Retinal fundus photograph; 1380x1382:
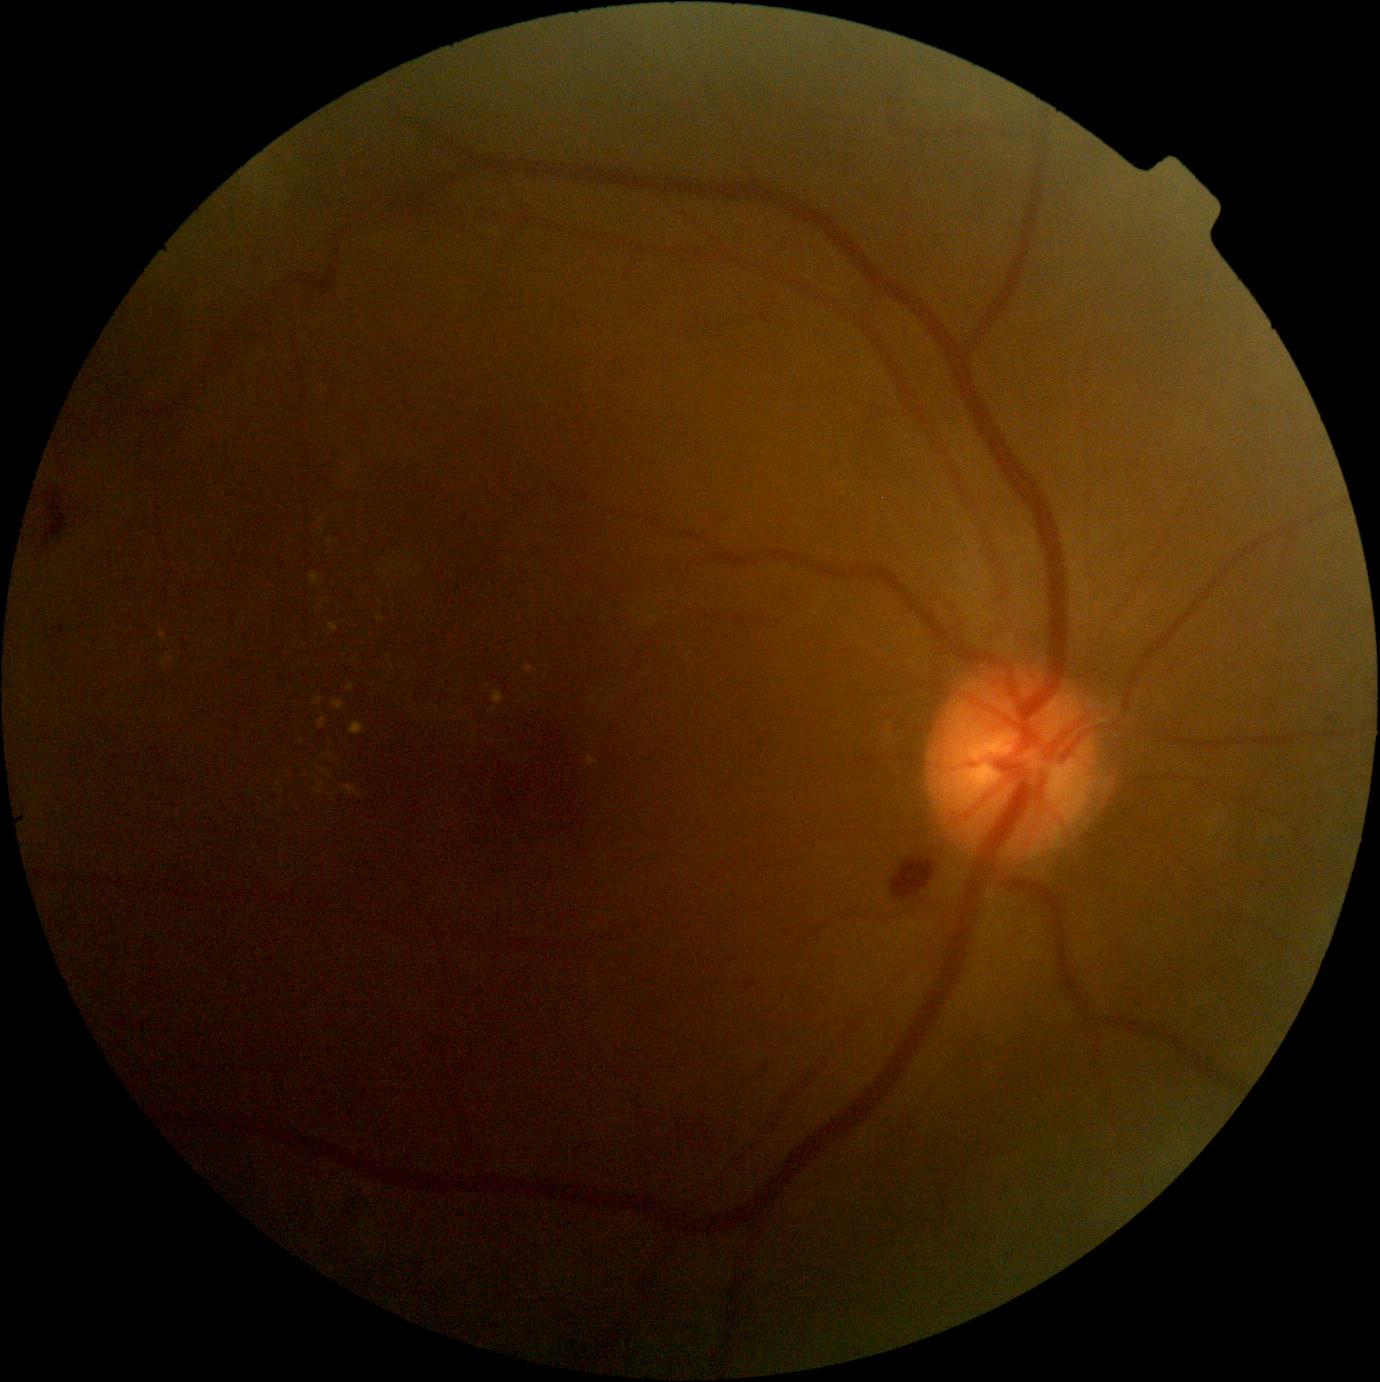 DR severity is grade 2 (moderate NPDR)
A subset of detected lesions:
HEs: box=[688, 1121, 725, 1162]; box=[385, 185, 442, 226]; box=[44, 491, 68, 544]; box=[892, 858, 936, 900]
EXs (partial): box=[276, 790, 284, 794]; box=[320, 769, 330, 778]; box=[323, 754, 333, 758]; box=[525, 666, 535, 673]; box=[346, 786, 359, 796]; box=[350, 723, 365, 735]; box=[333, 701, 345, 711]; box=[318, 719, 327, 730]
Additional small EXs near {"x": 302, "y": 742}; {"x": 321, "y": 534}; {"x": 170, "y": 657}; {"x": 380, "y": 617}; {"x": 605, "y": 708}; {"x": 537, "y": 697}
SEs: none detected
Additional small MAs near {"x": 1331, "y": 719}